Optic disc-centered crop from a color fundus photograph: 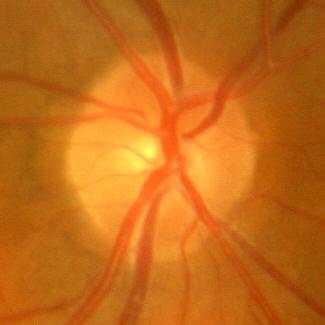 Glaucoma status = no glaucoma.